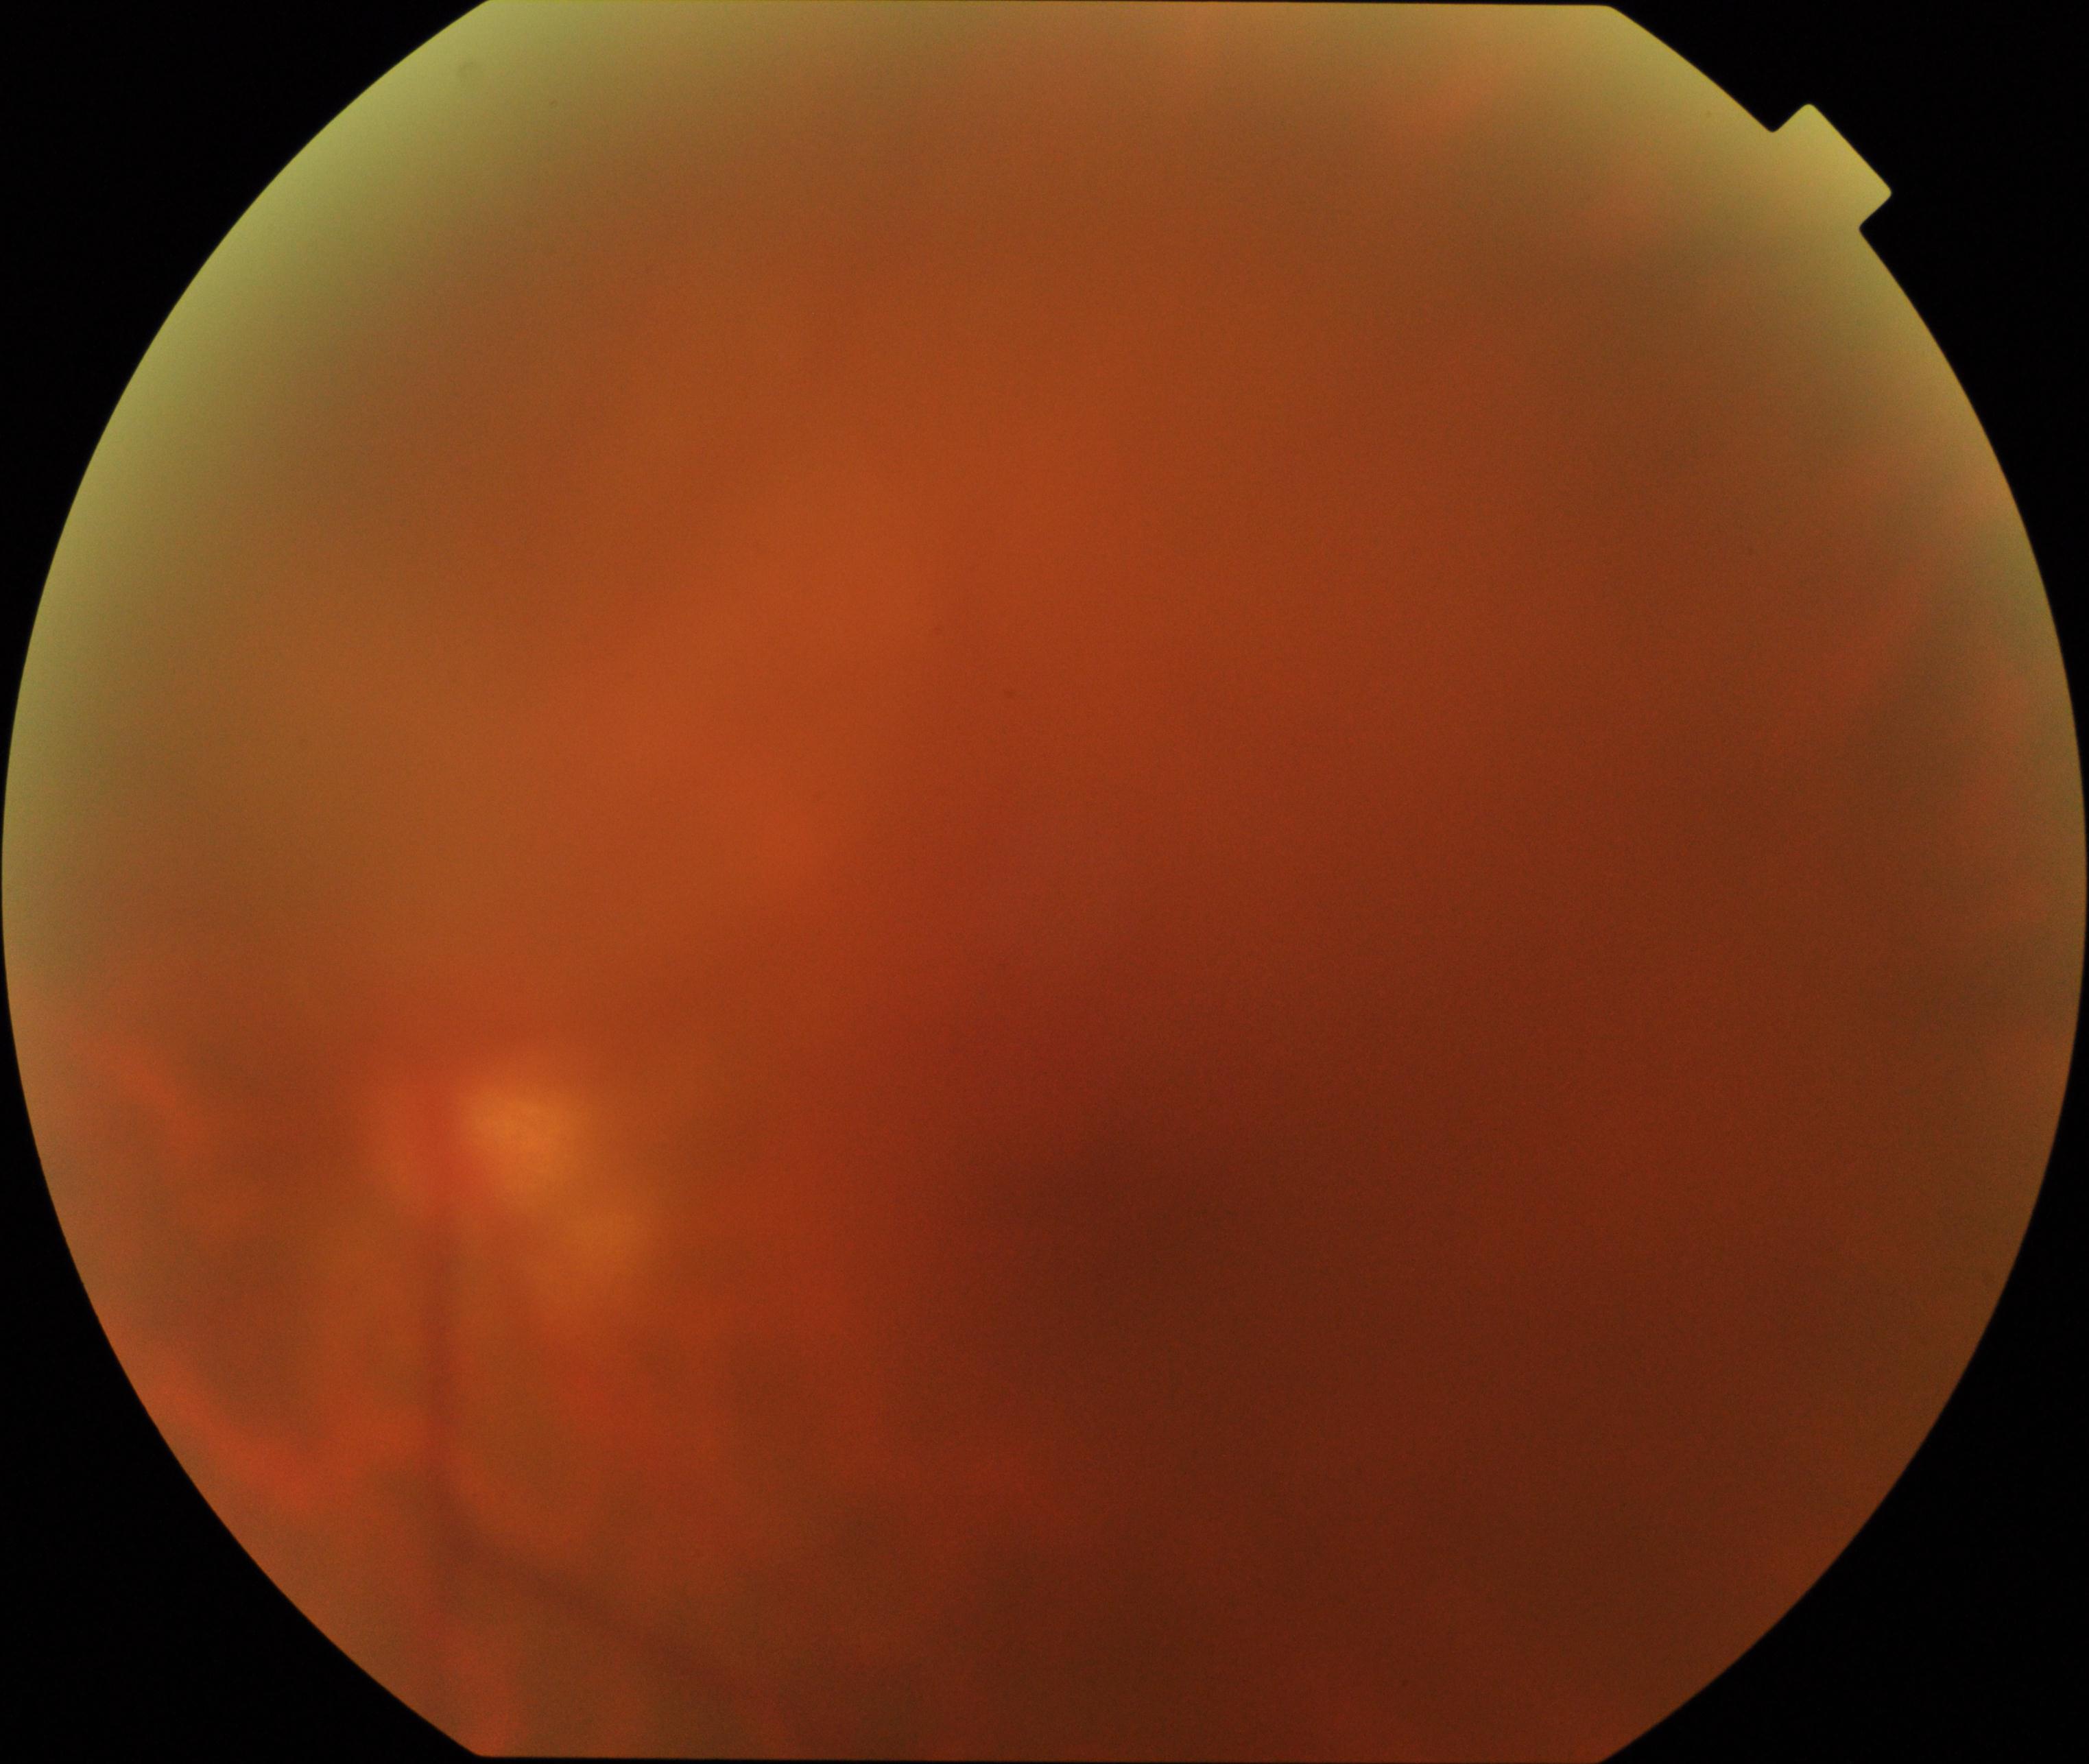 Gradability: poor, substantial obscuration of retinal landmarks.
Proliferative retinopathy: absent.